Color fundus photograph · captured on a Remidio smartphone fundus camera:
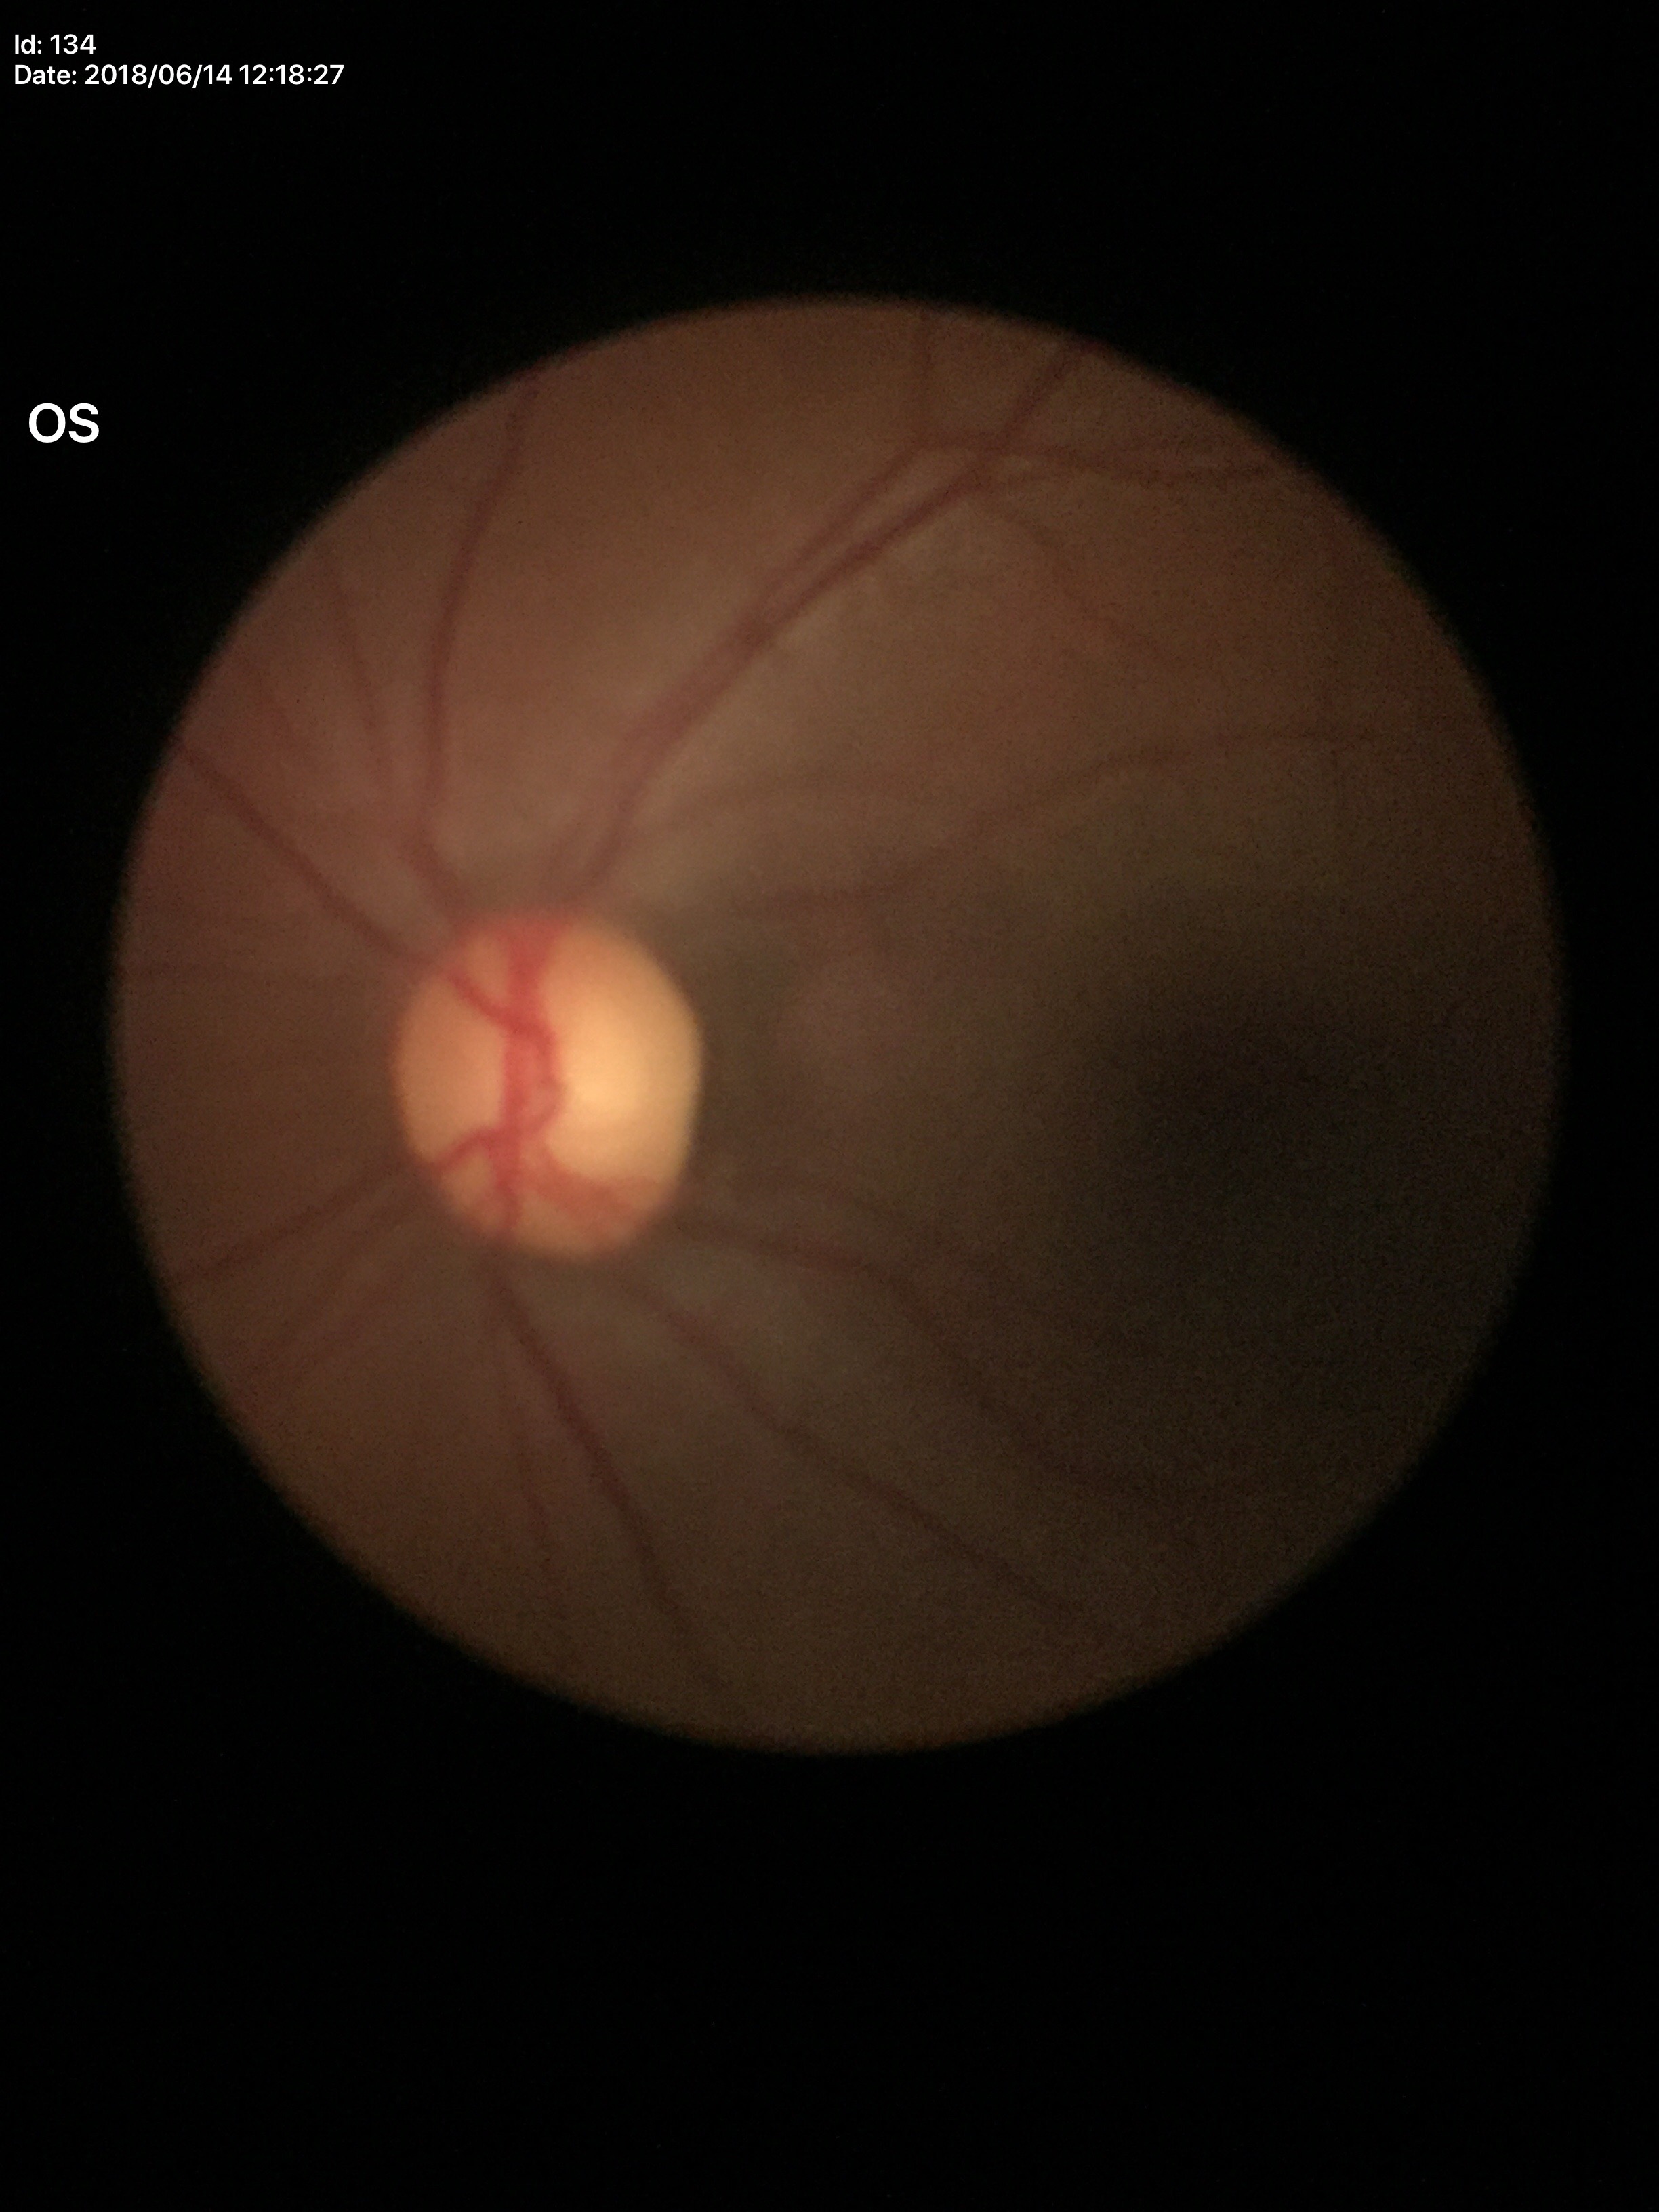 No evidence of glaucoma (2 of 5 graders flagged glaucoma suspect).
Vertical cup-to-disc ratio is 0.59.